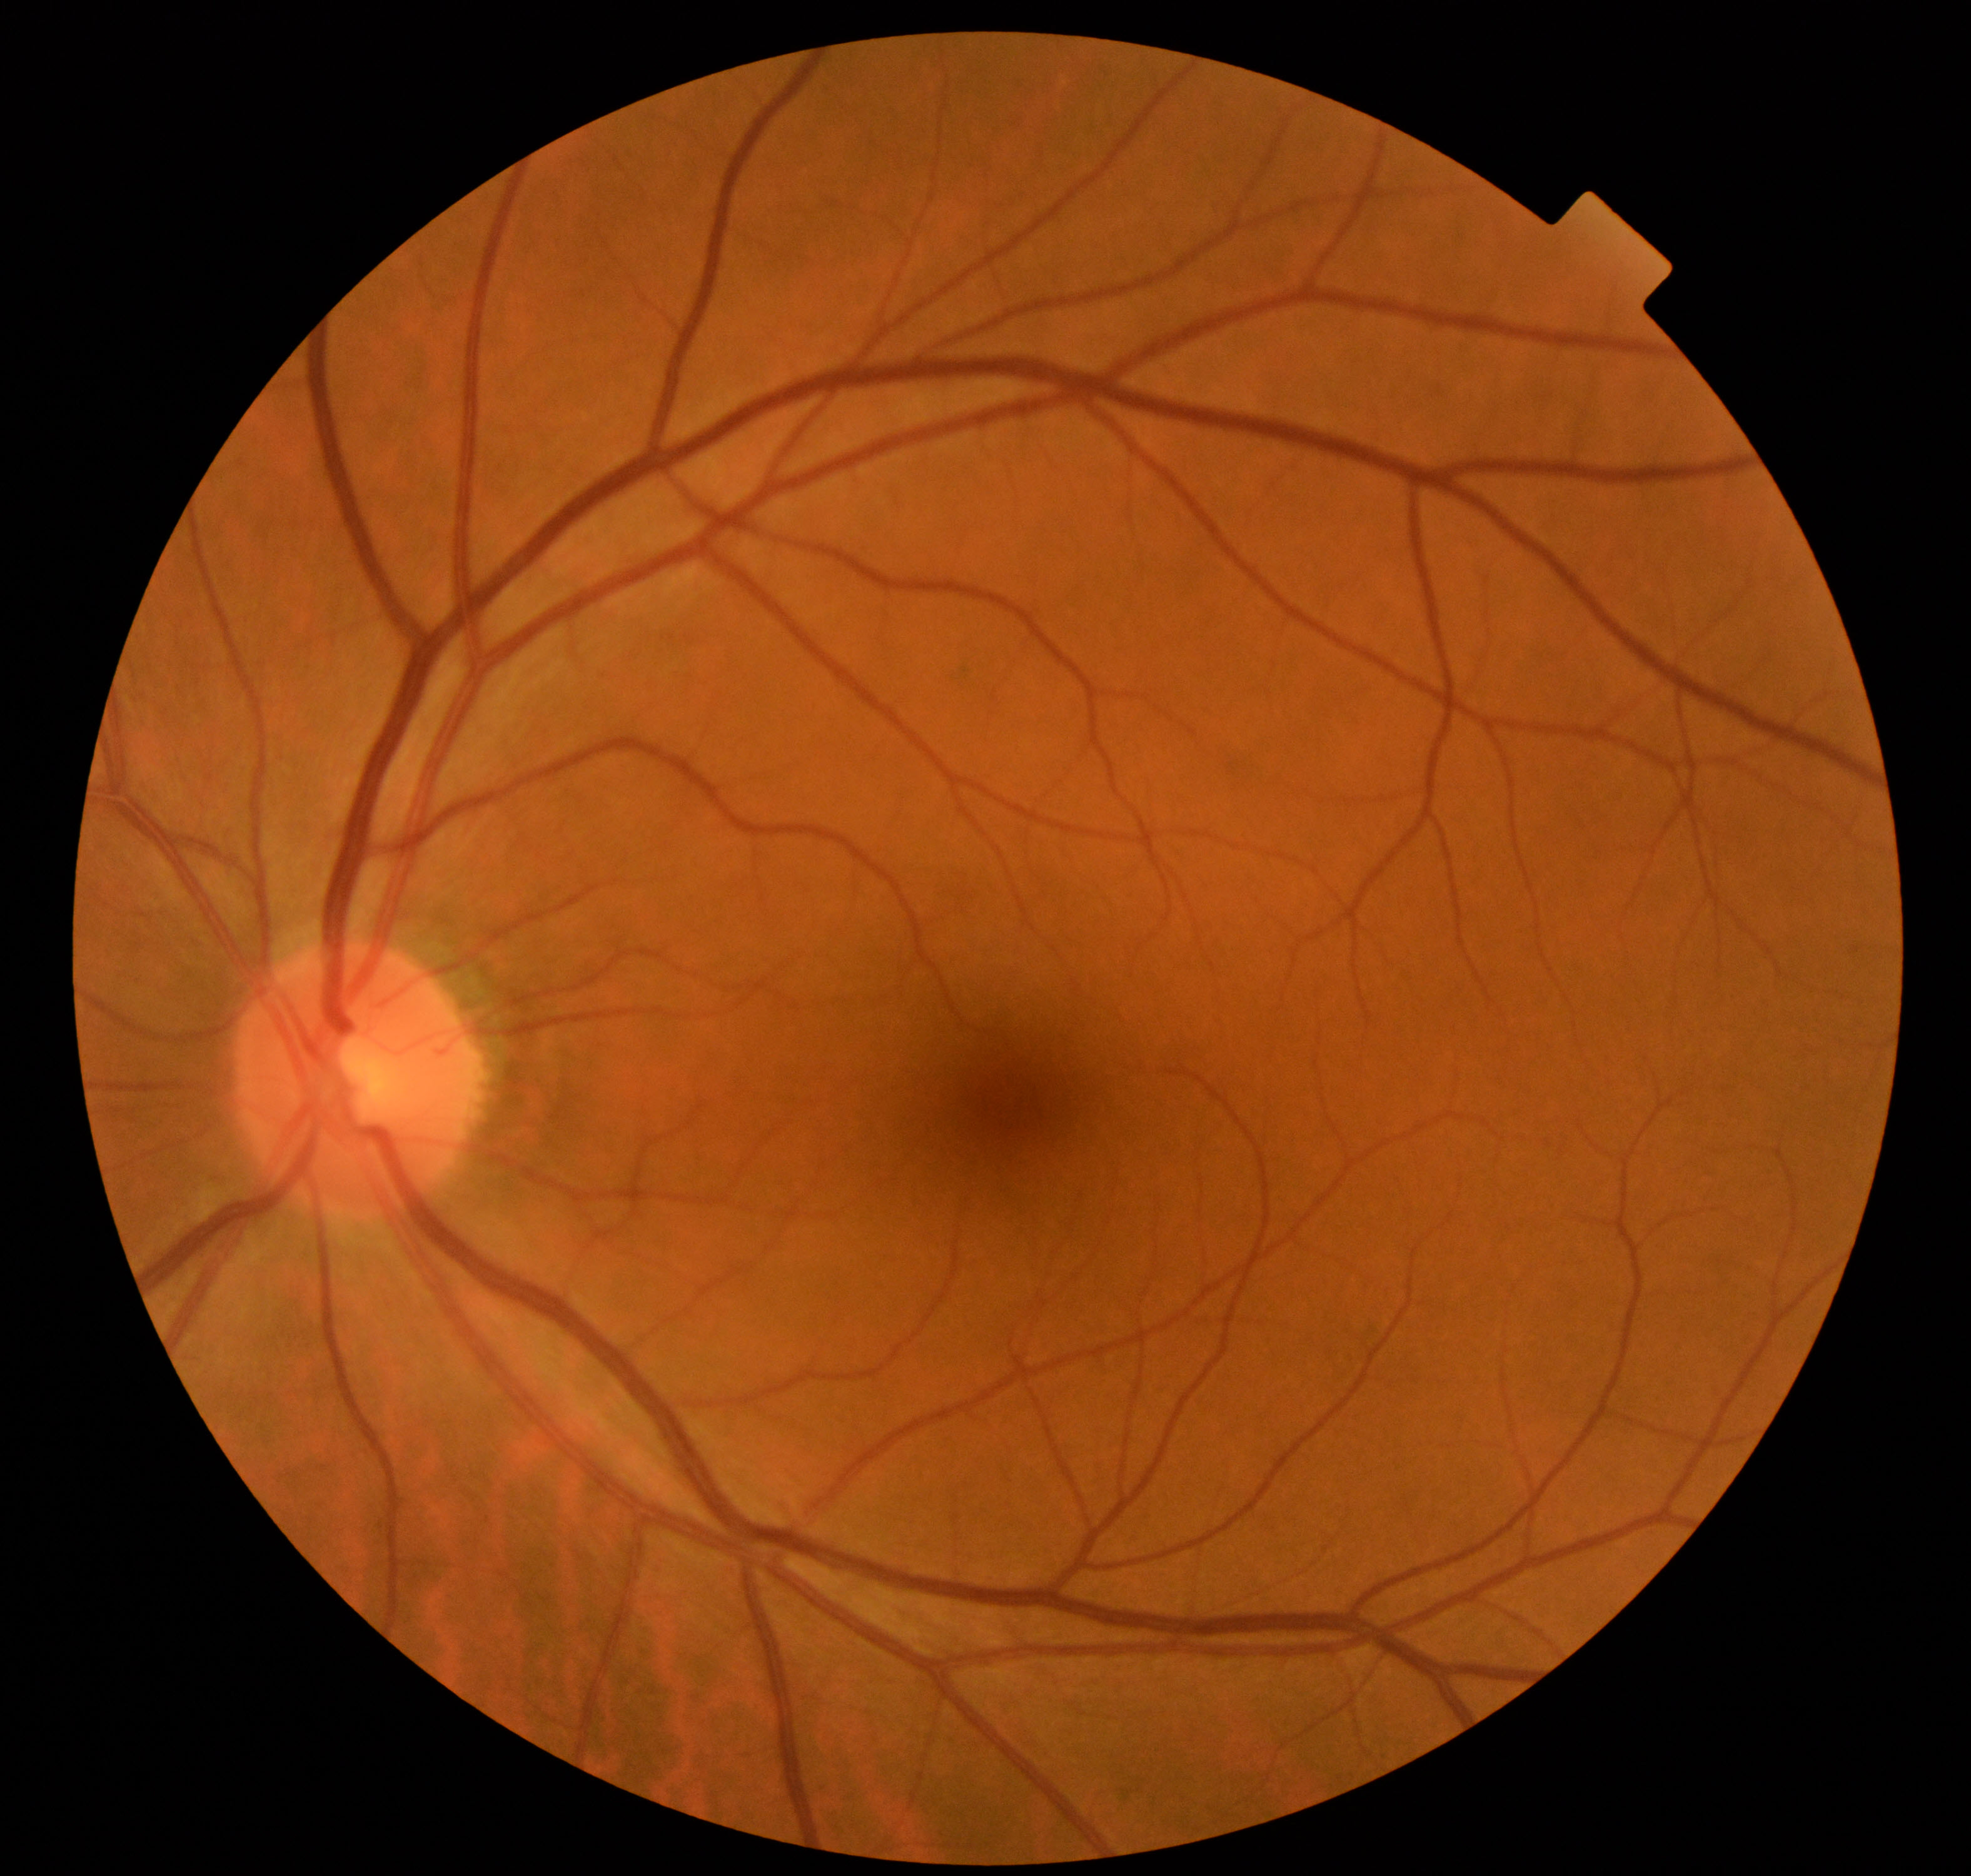 Impression: within normal limits.